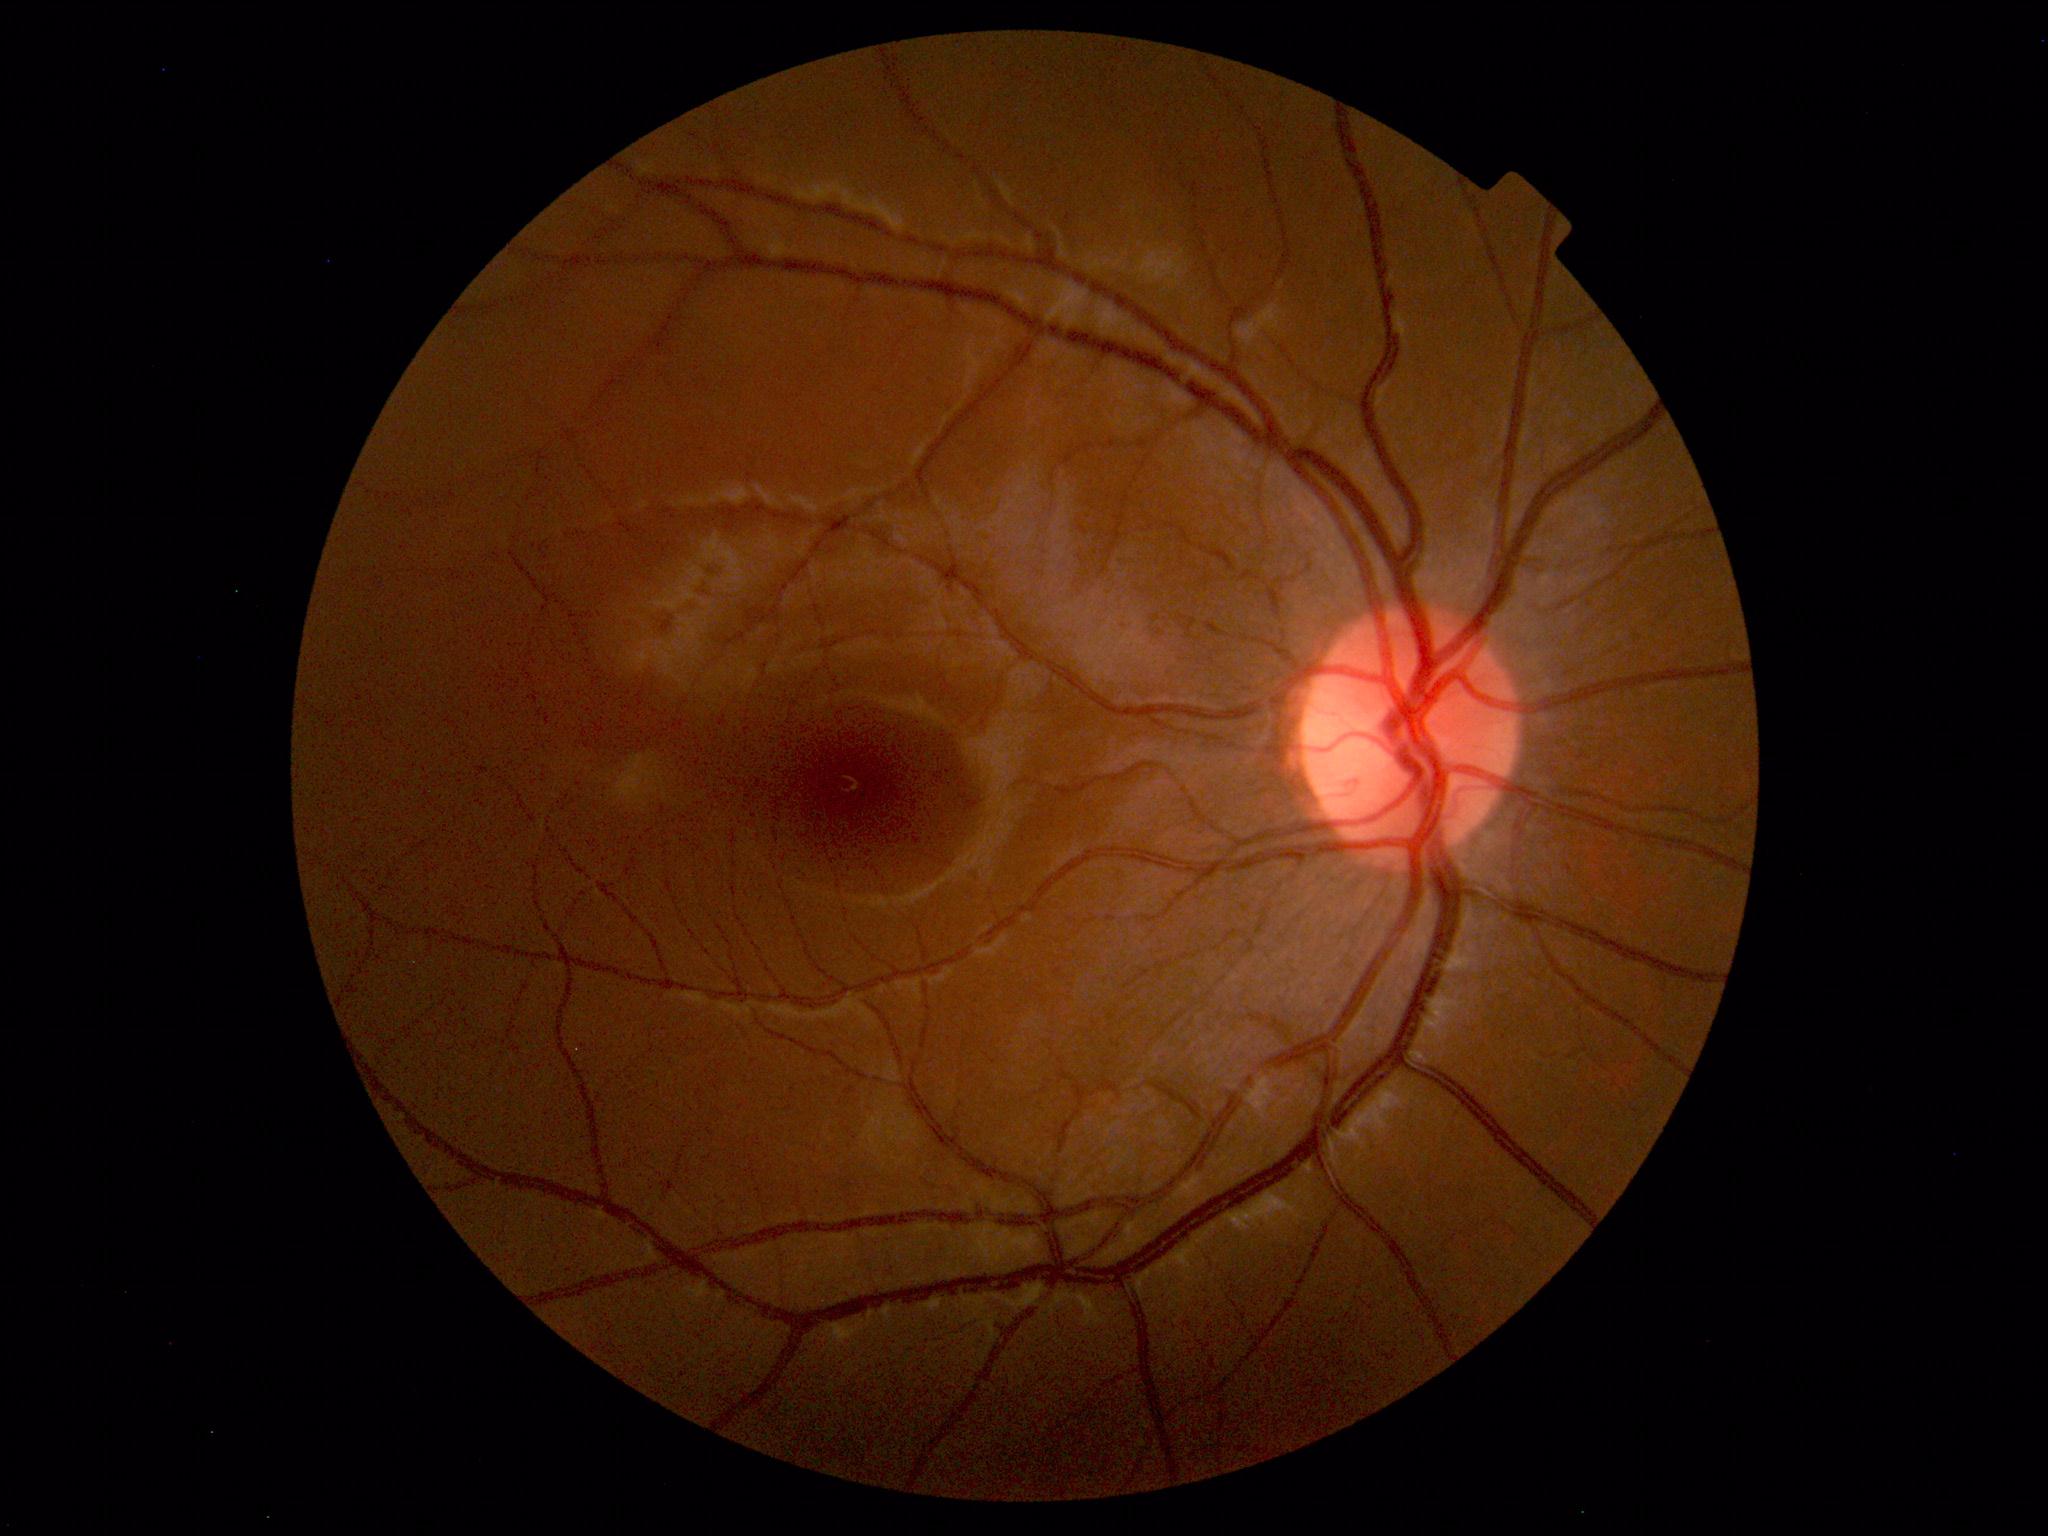

Fundus photograph within normal limits.